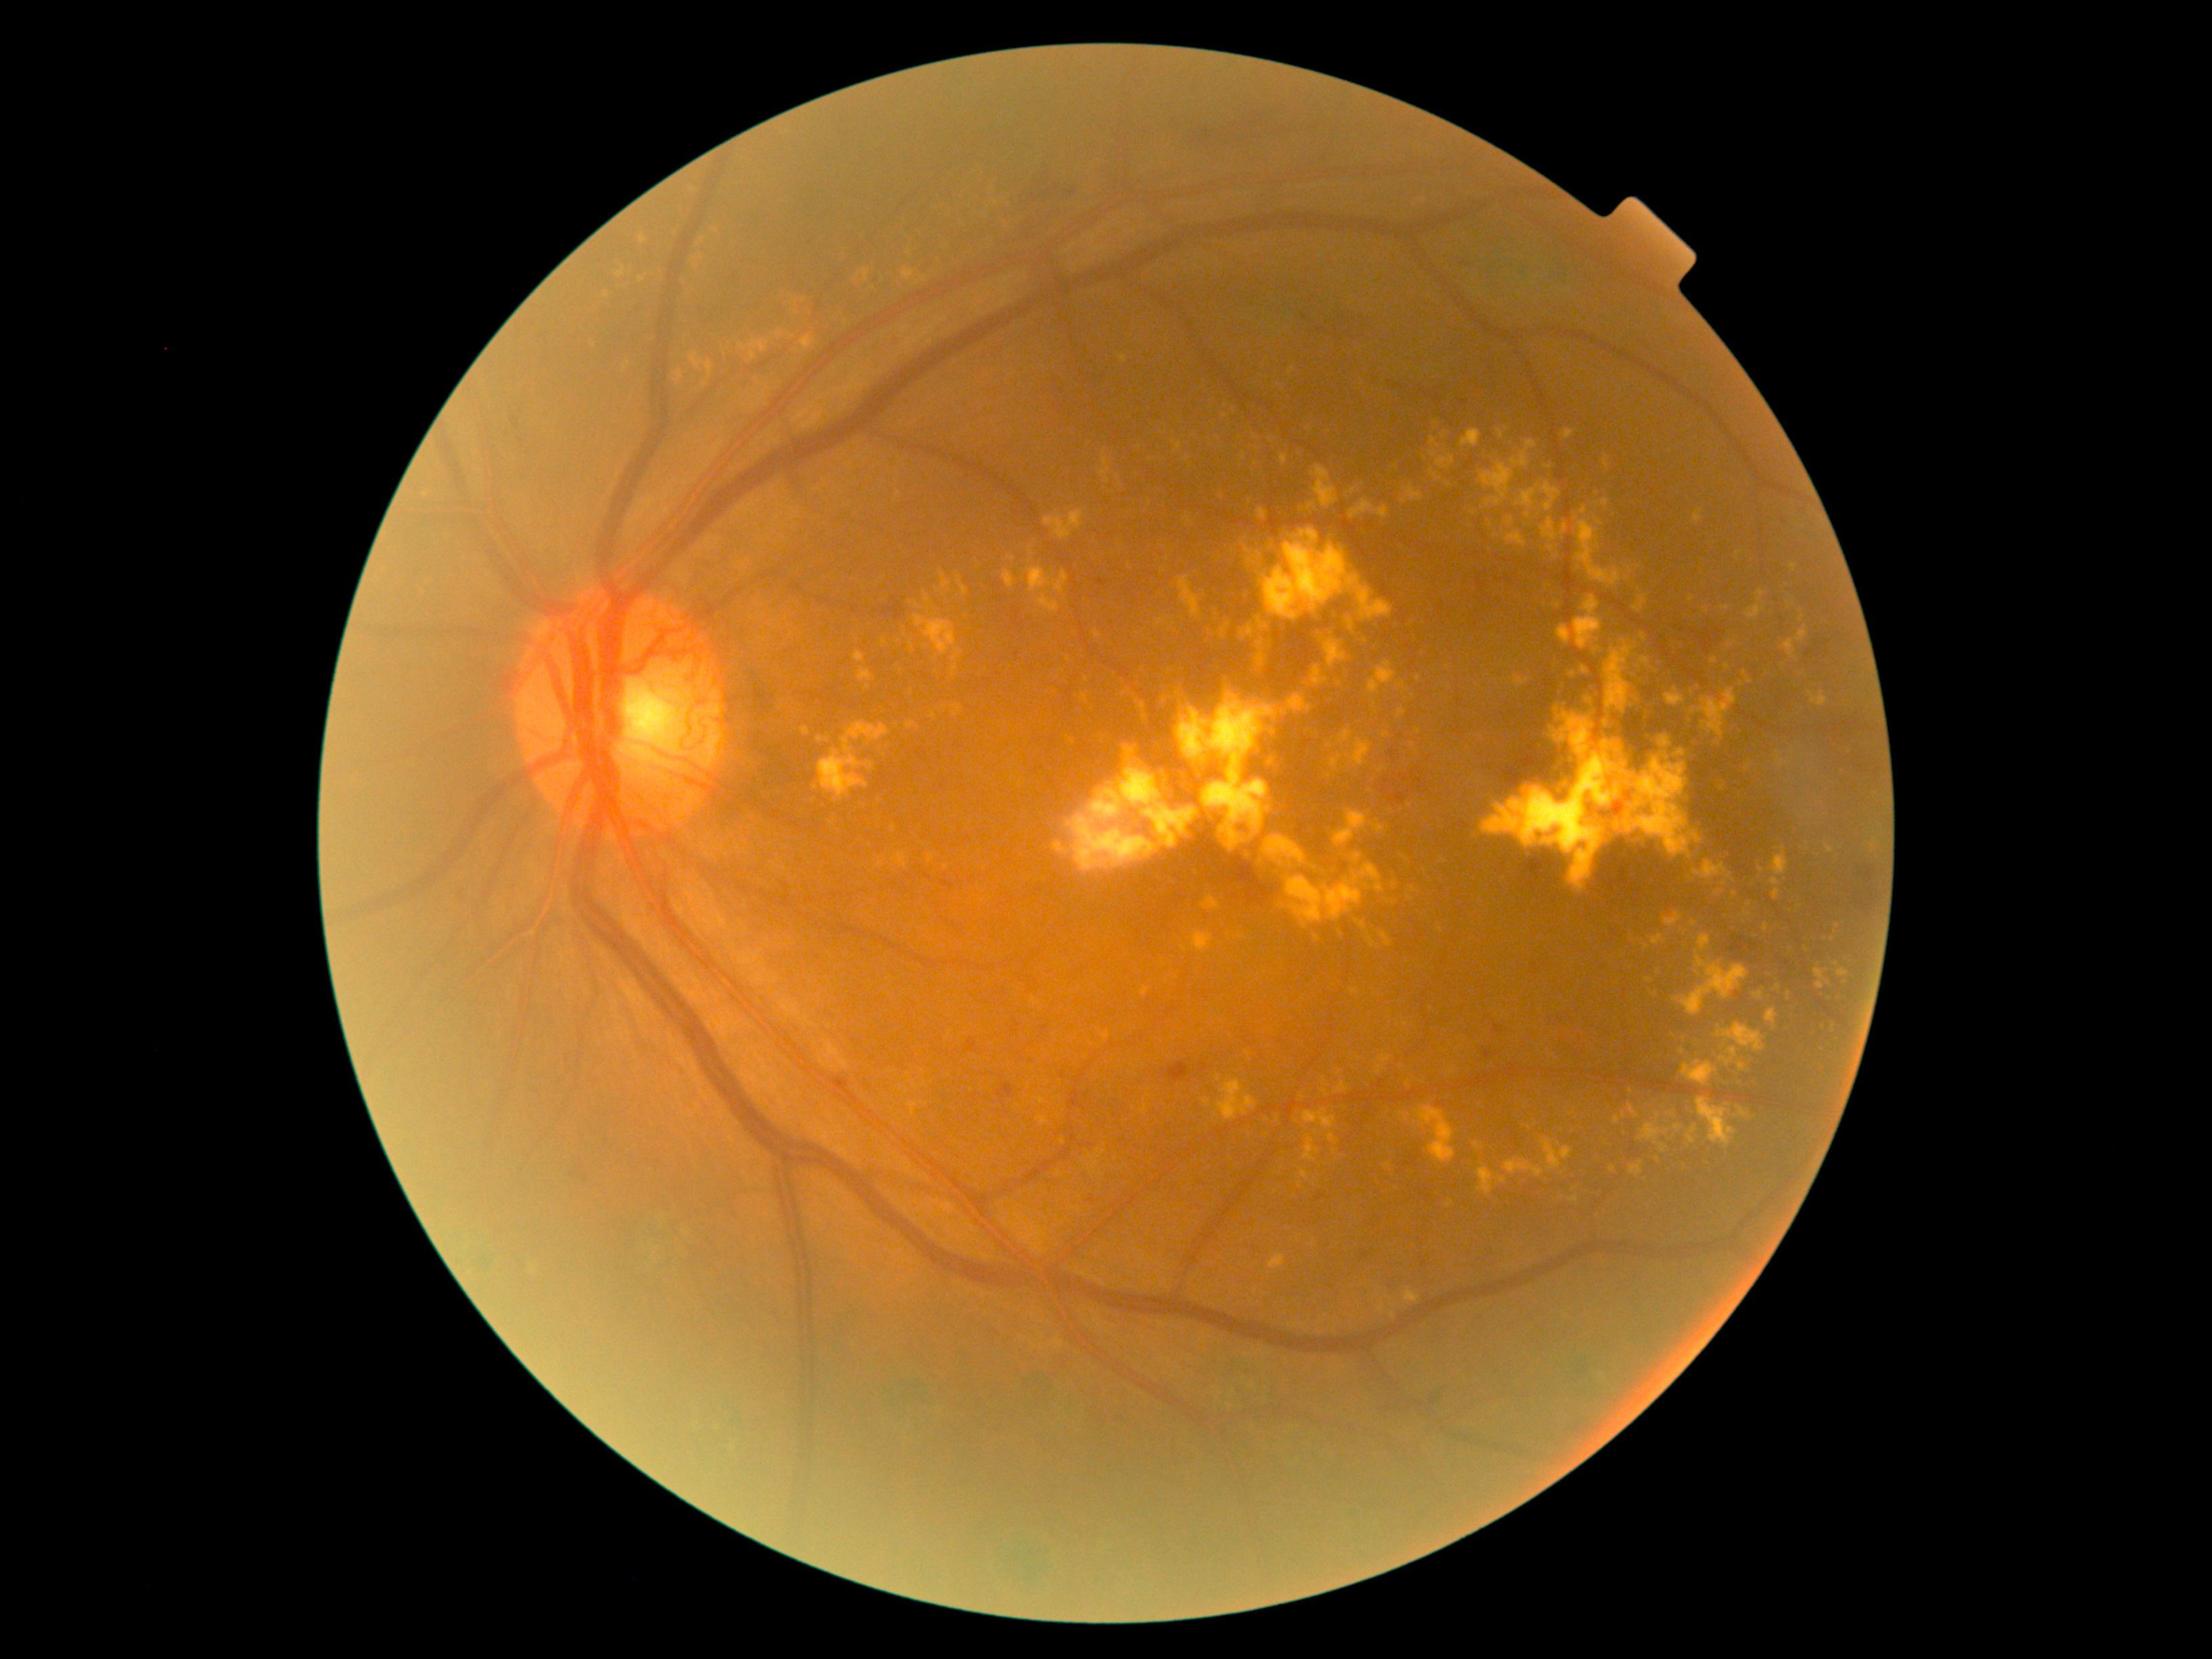
DR severity is 4
A subset of detected lesions:
EXs (more not shown) = <region>1661, 1145, 1665, 1154</region>; <region>1269, 1254, 1286, 1269</region>; <region>1349, 499, 1389, 520</region>; <region>1798, 626, 1809, 643</region>; <region>1039, 593, 1061, 612</region>; <region>1821, 1021, 1832, 1028</region>; <region>1244, 834, 1254, 842</region>; <region>1696, 1099, 1737, 1147</region>; <region>1253, 436, 1261, 441</region>; <region>1038, 1115, 1050, 1126</region>; <region>1162, 775, 1166, 790</region>; <region>895, 491, 901, 501</region>; <region>1611, 823, 1623, 833</region>
EXs (small, approximate centers) near <pt>1779,988</pt>; <pt>1222,497</pt>; <pt>893,828</pt>; <pt>1718,893</pt>; <pt>1448,667</pt>; <pt>1647,947</pt>; <pt>1418,732</pt>